Without pupil dilation · 45° FOV: 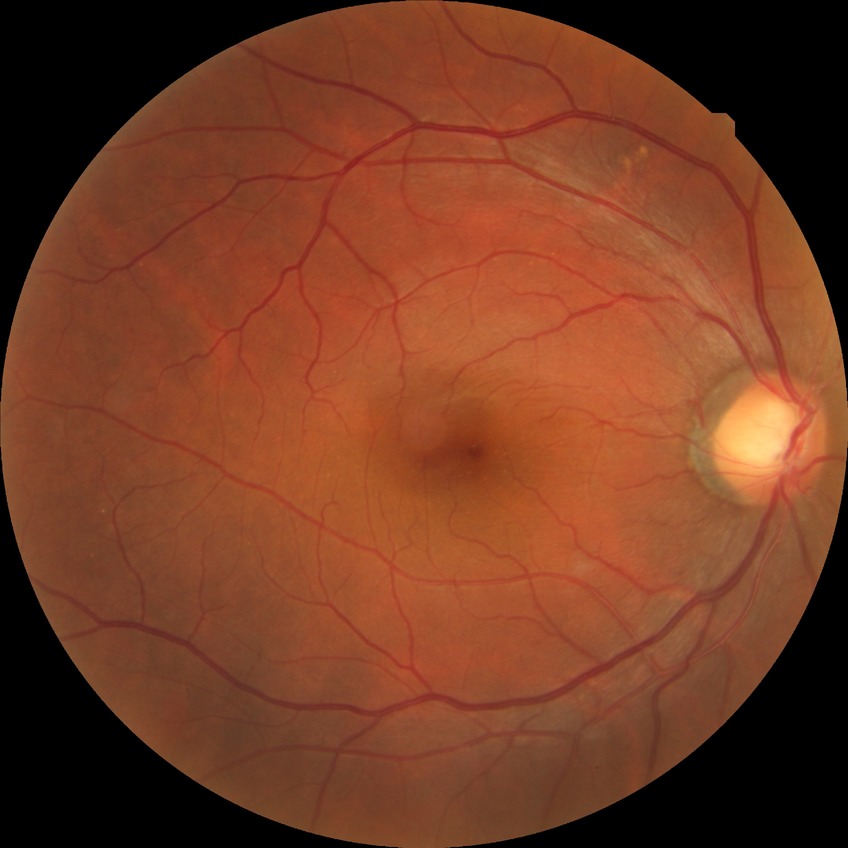 retinopathy stage = no diabetic retinopathy.